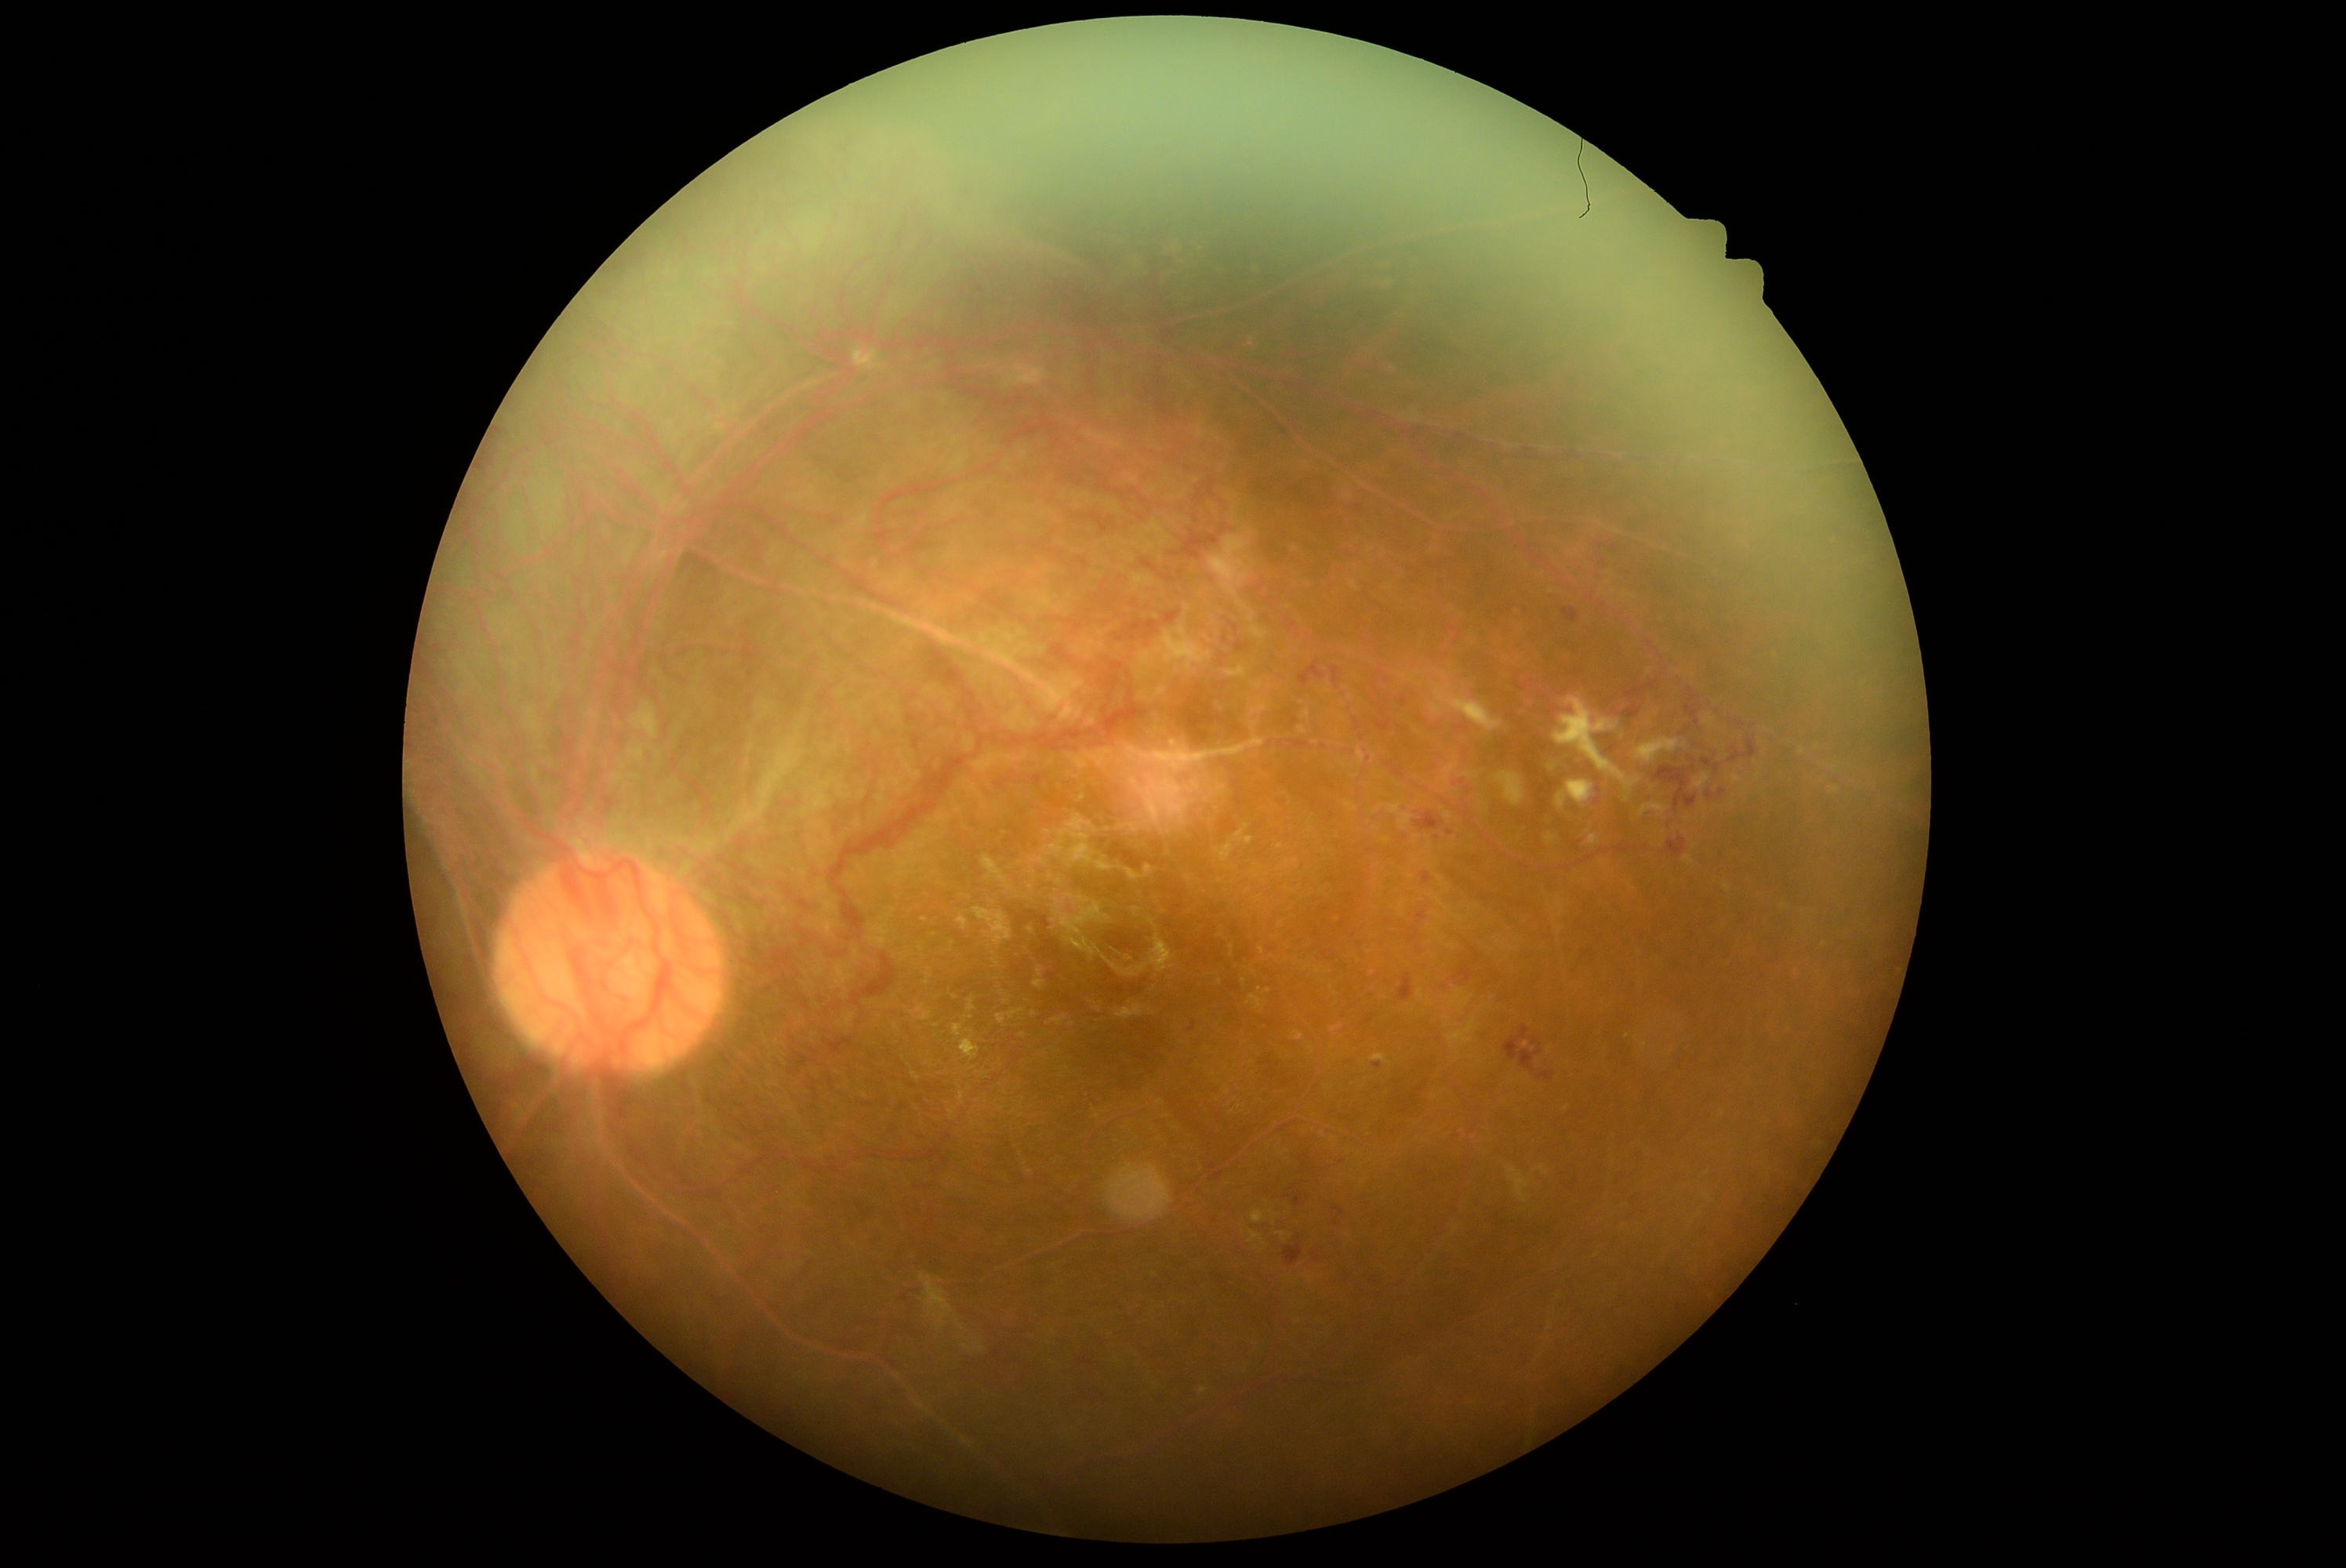
DR class: proliferative diabetic retinopathy. Retinopathy grade is 4 (PDR).